Image size 848x848; 45 degree fundus photograph; NIDEK AFC-230; modified Davis grading.
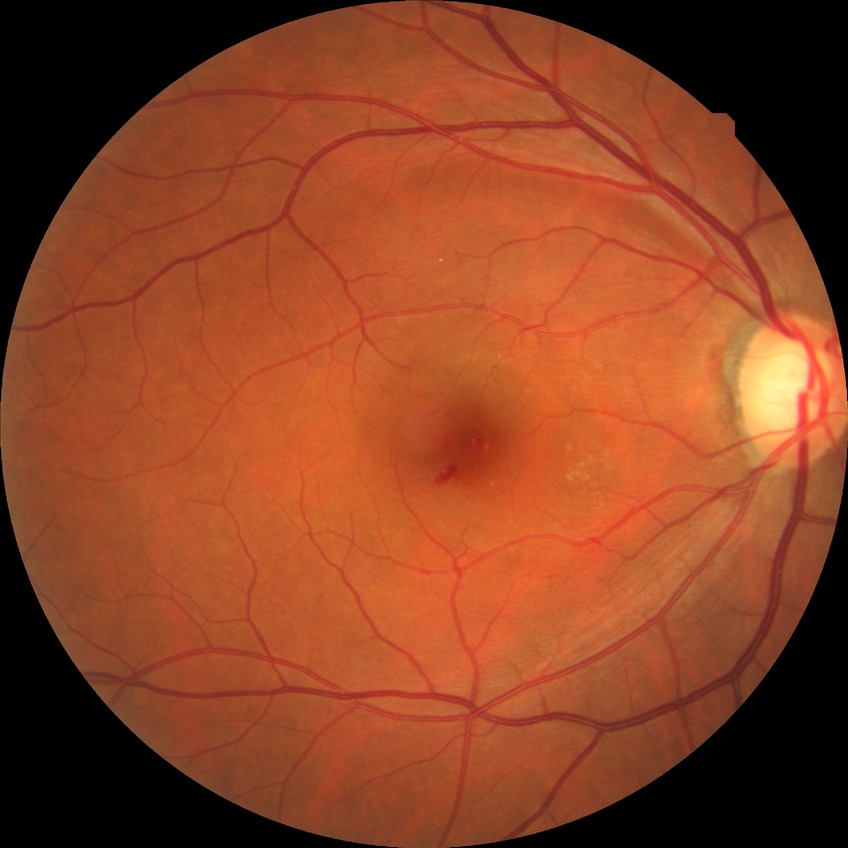
DR grade: NDR.